Camera: NIDEK AFC-230, Davis DR grading.
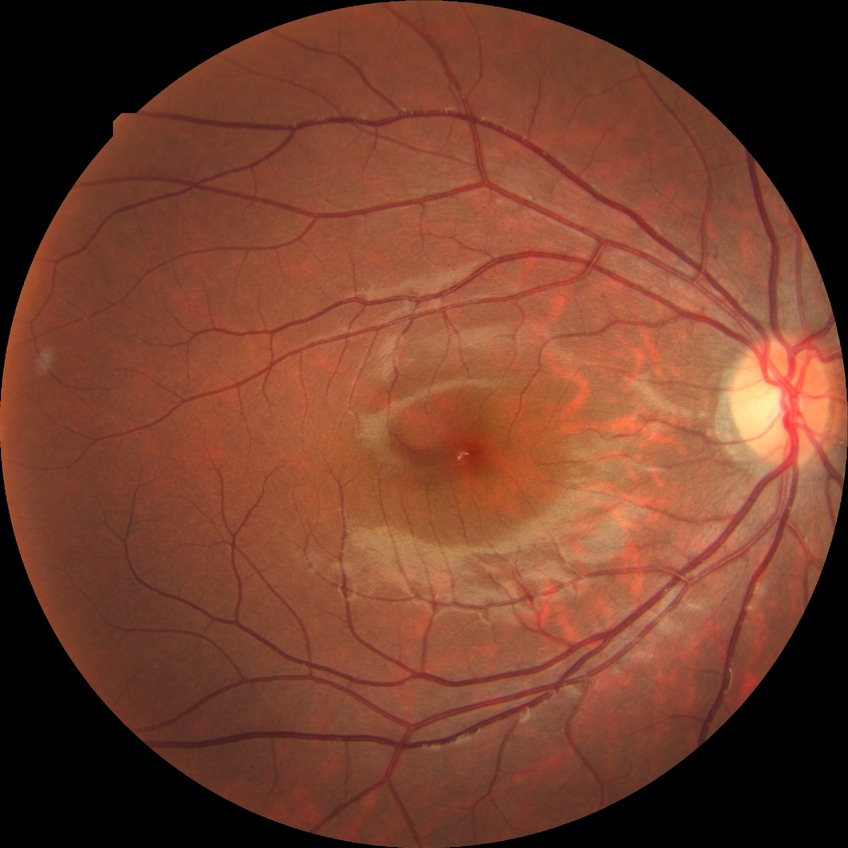
diabetic retinopathy (DR): NDR (no diabetic retinopathy).